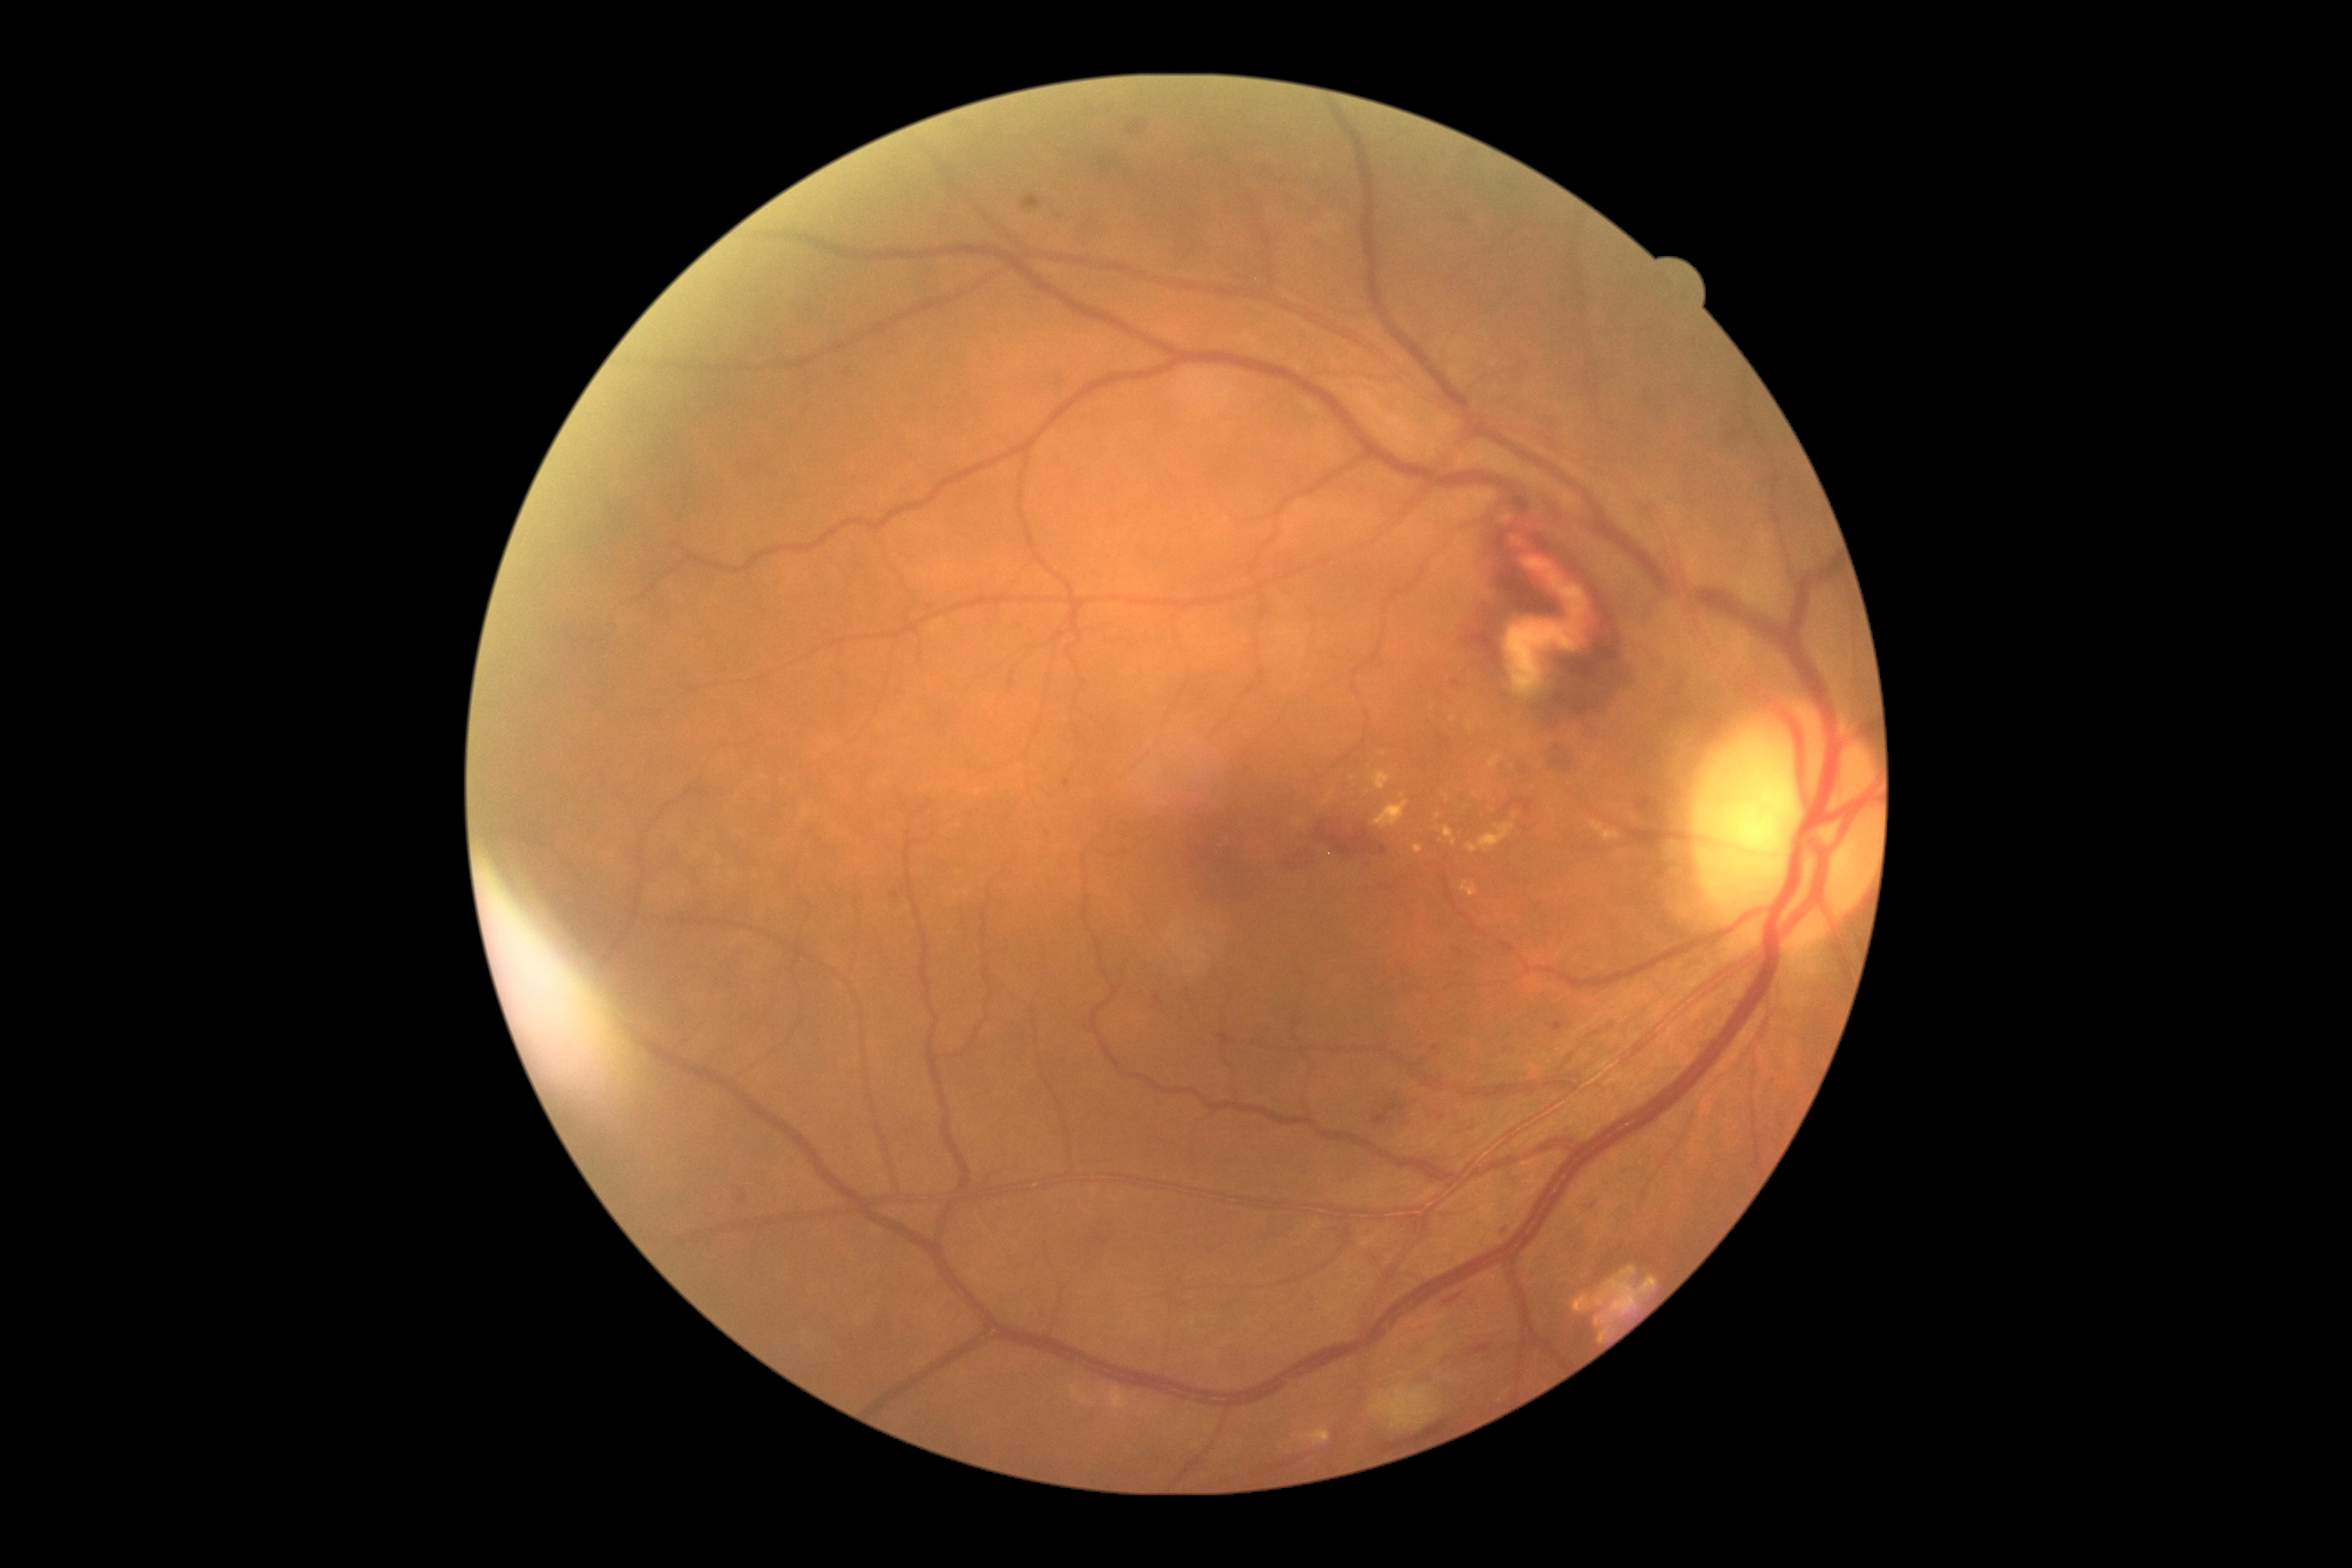
{"dr_grade": "2"}